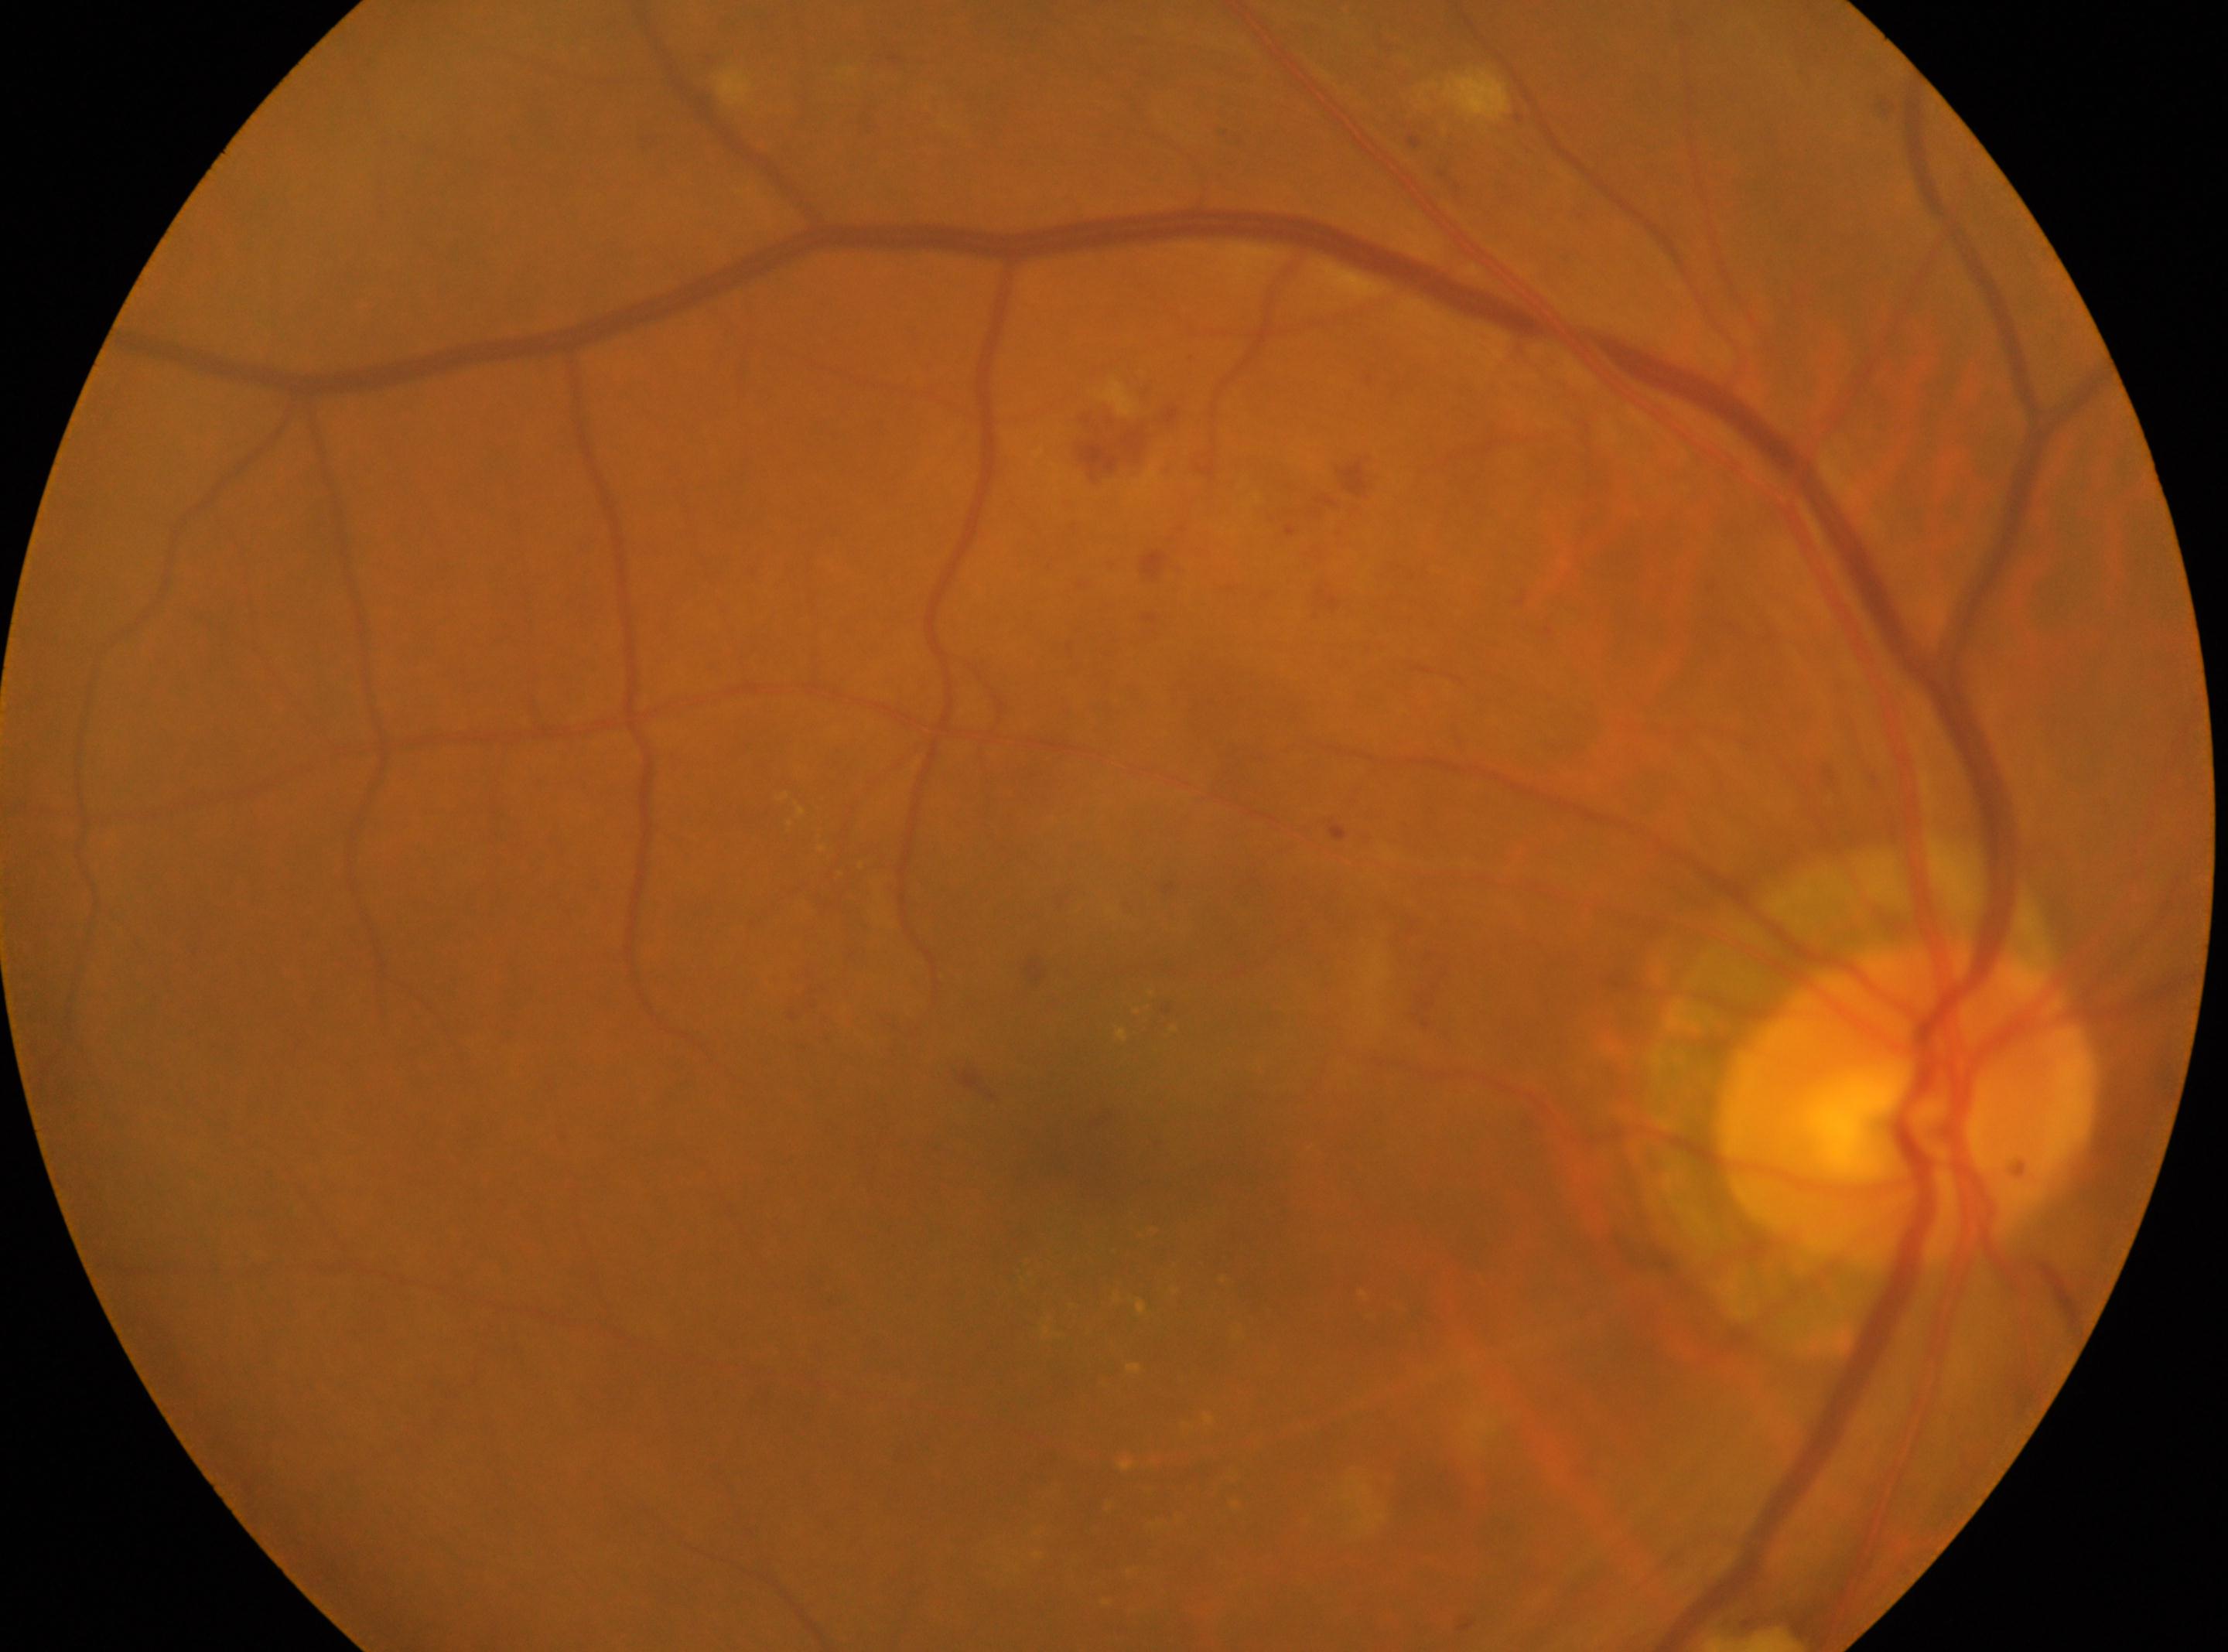 diabetic retinopathy (DR)=grade 2 (moderate NPDR) — more than just microaneurysms but less than severe NPDR
right
foveal center=(1089,1145)
disc center=(1905,1104)